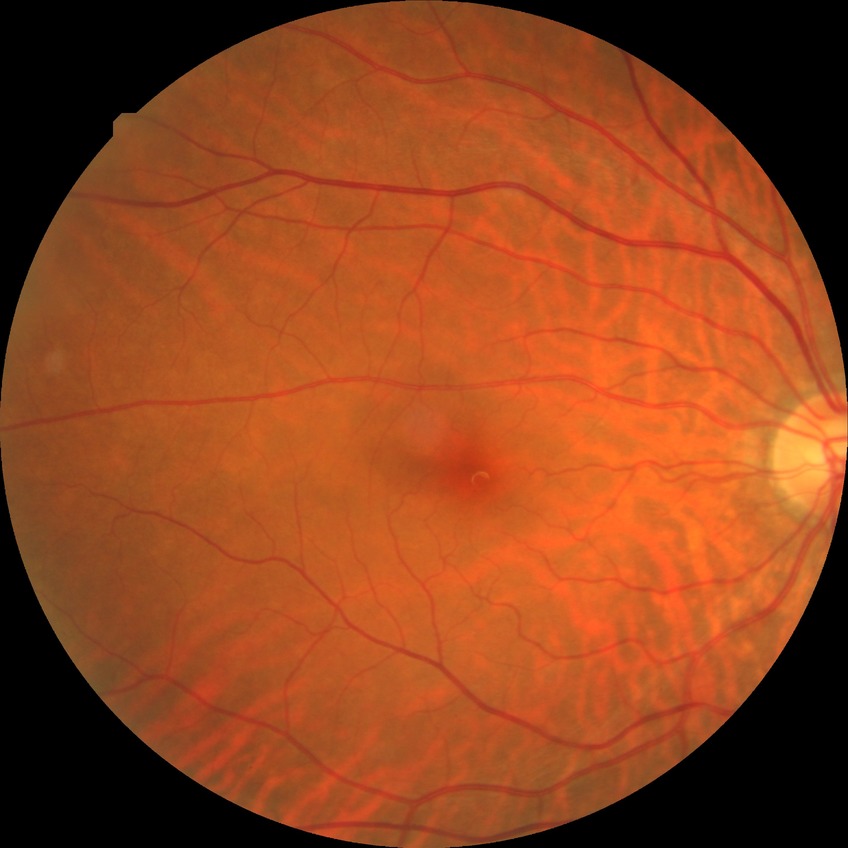

diabetic retinopathy (DR): no diabetic retinopathy (NDR)